FOV: 45 degrees. 2352 x 1568 pixels.
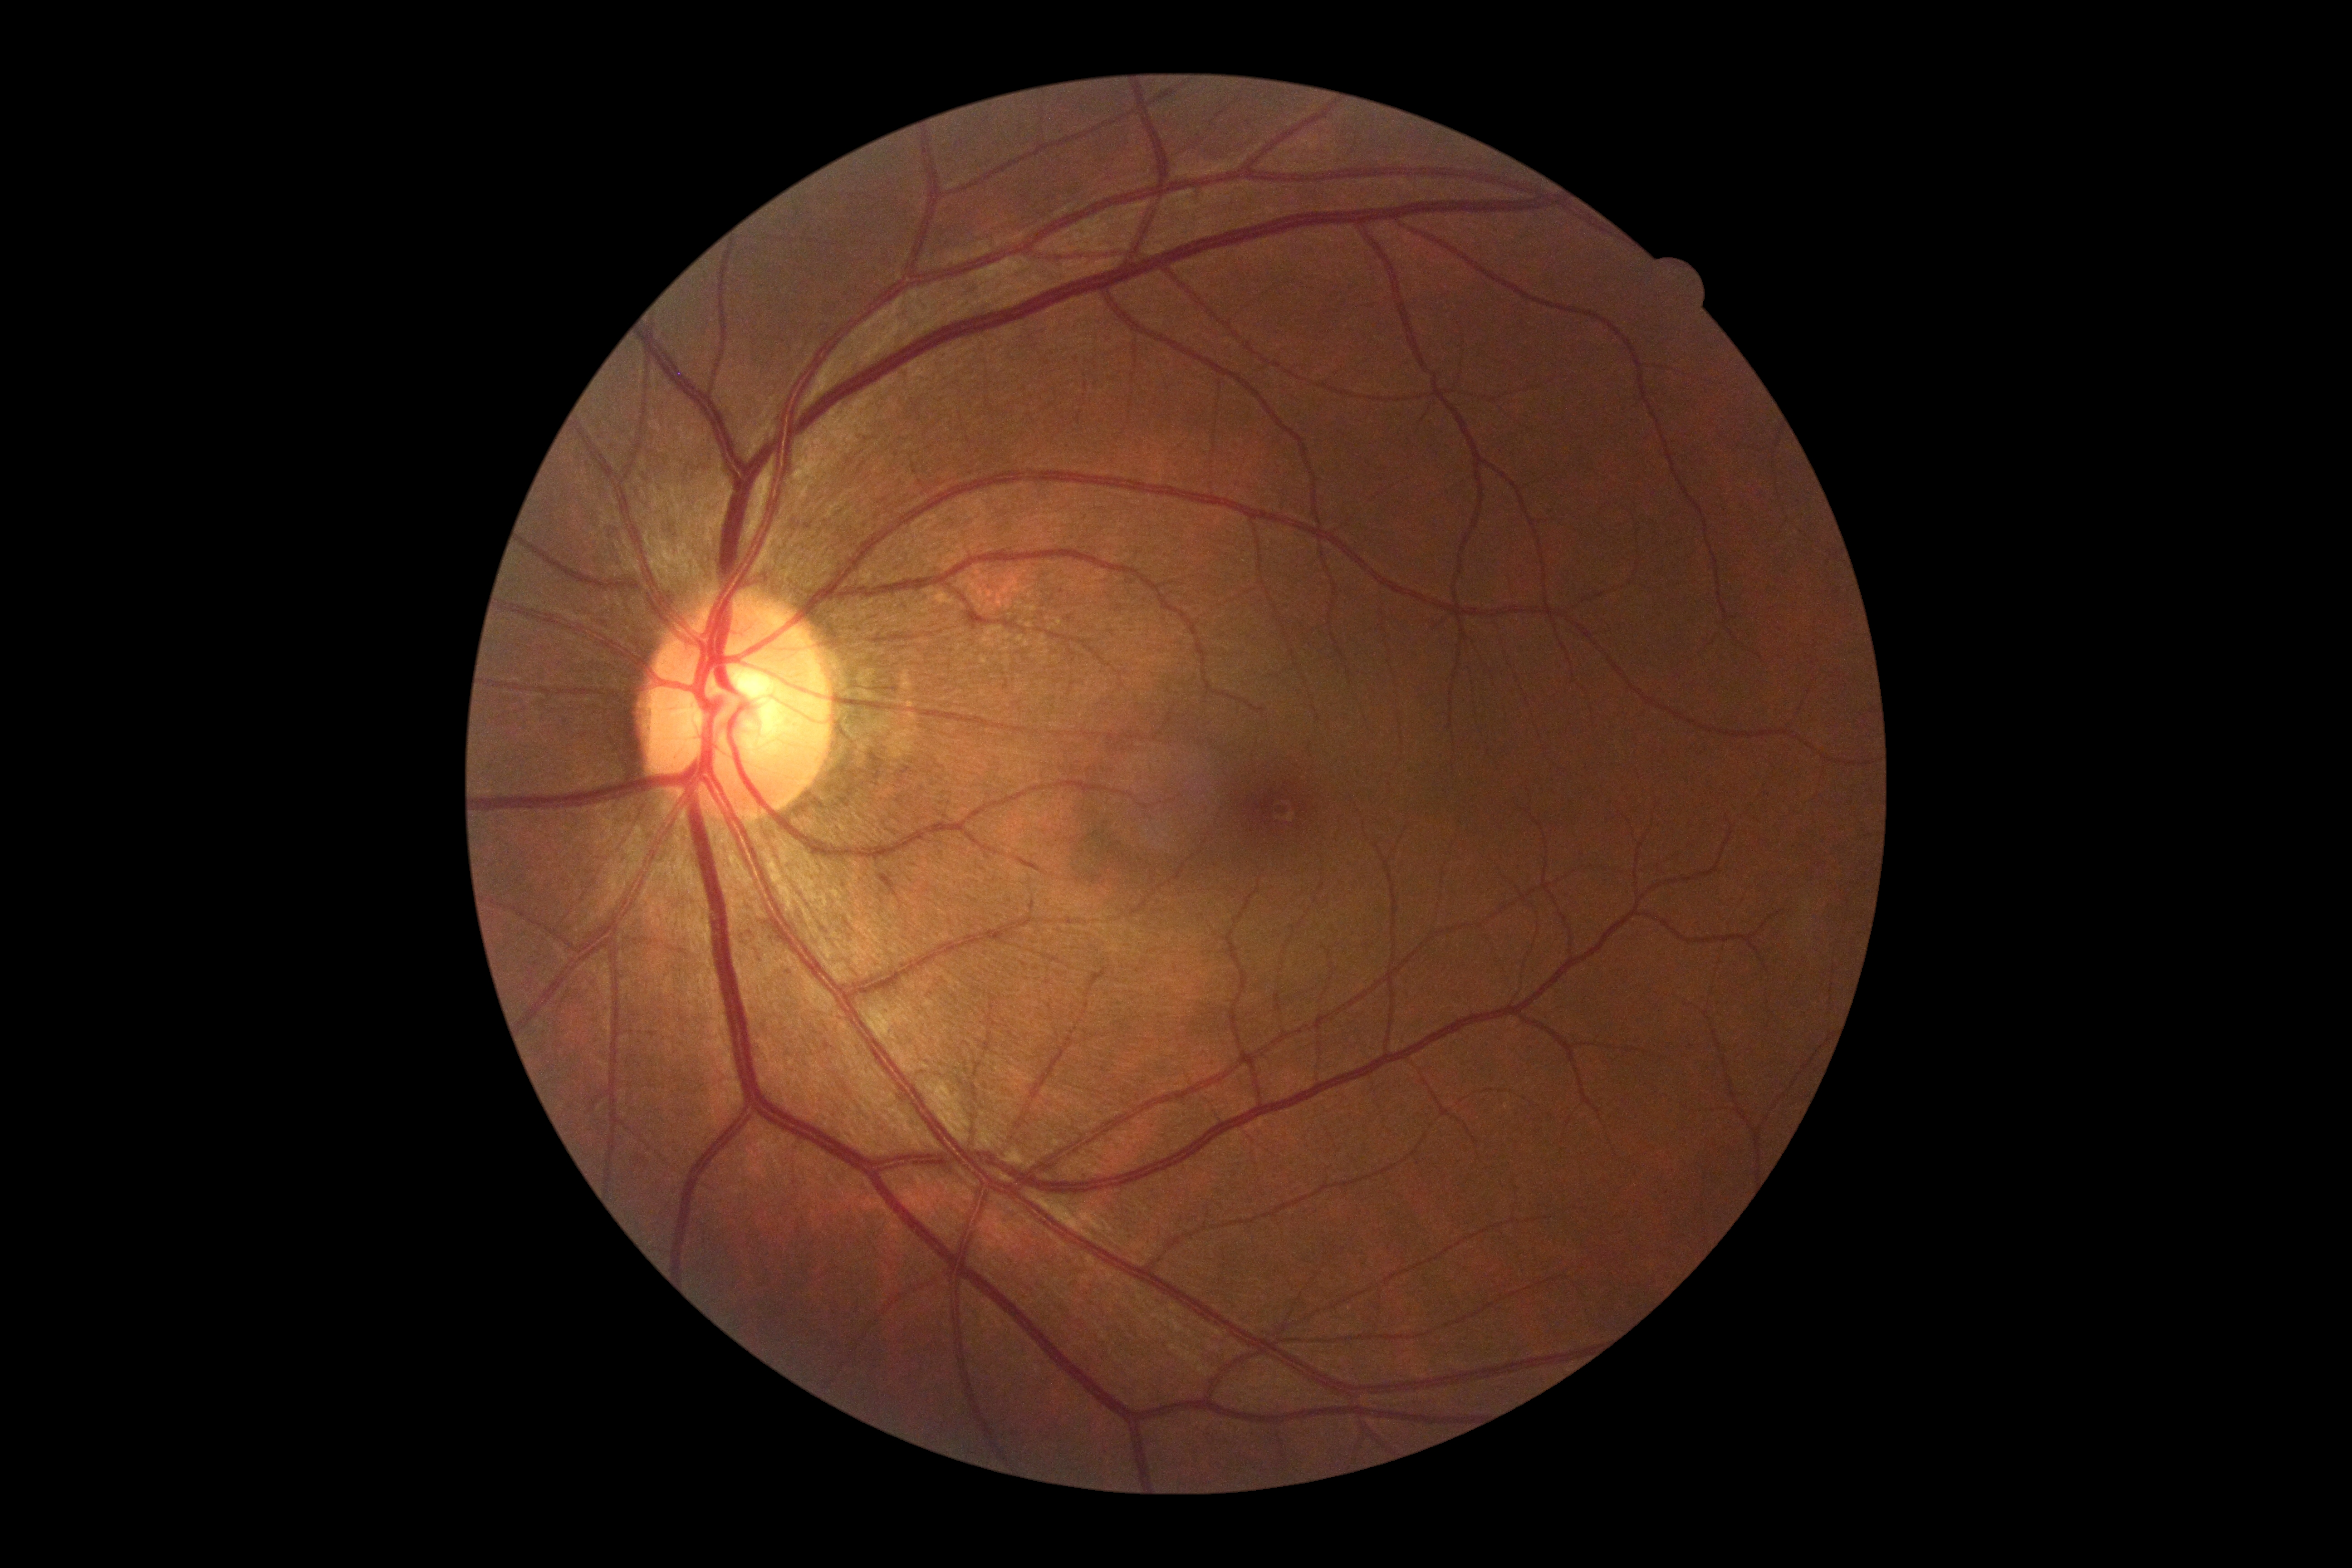

Retinopathy grade: no apparent retinopathy (0).